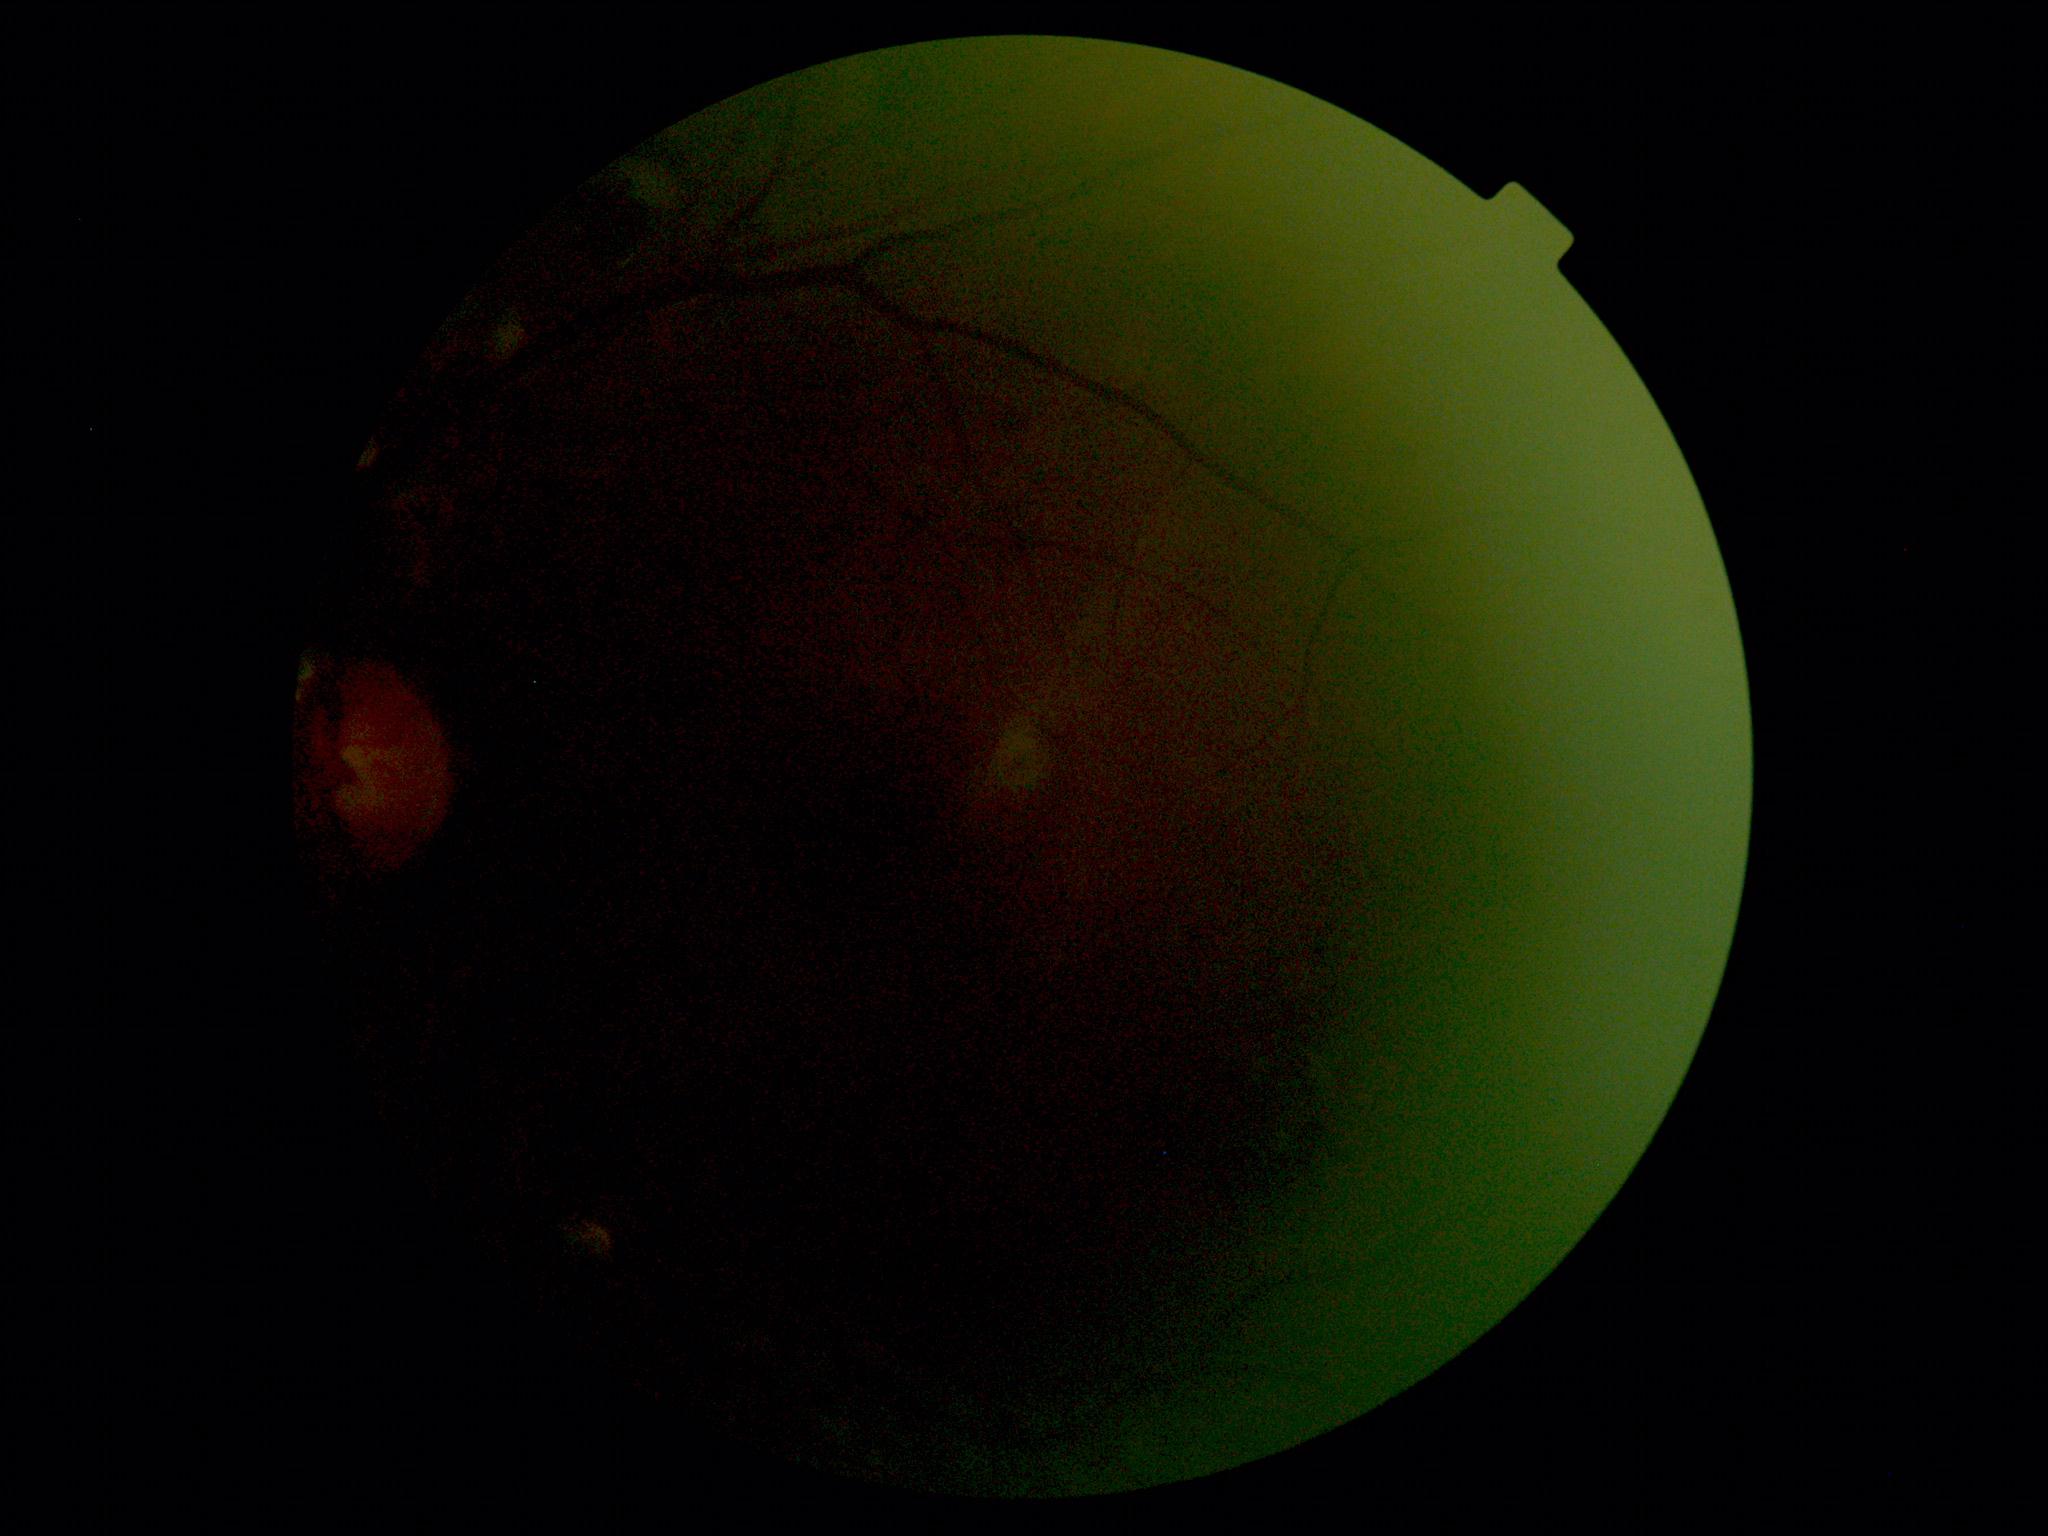 DR: ungradable due to poor image quality. Image quality is insufficient for diabetic retinopathy assessment.